Modified Davis grading:
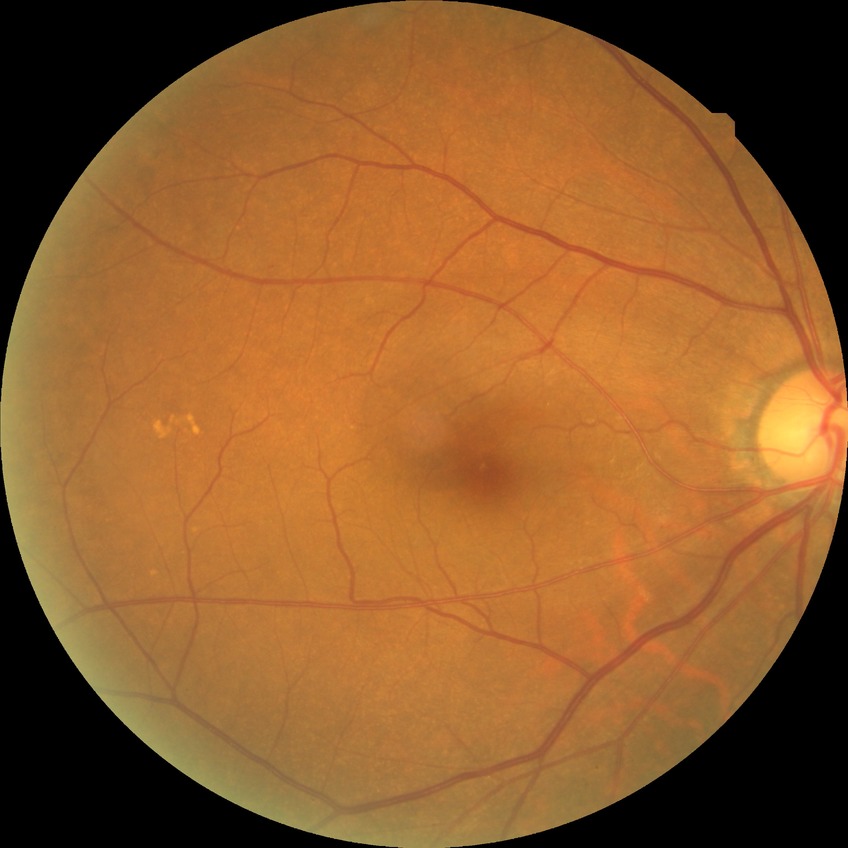 DR grade is NDR. No signs of diabetic retinopathy.